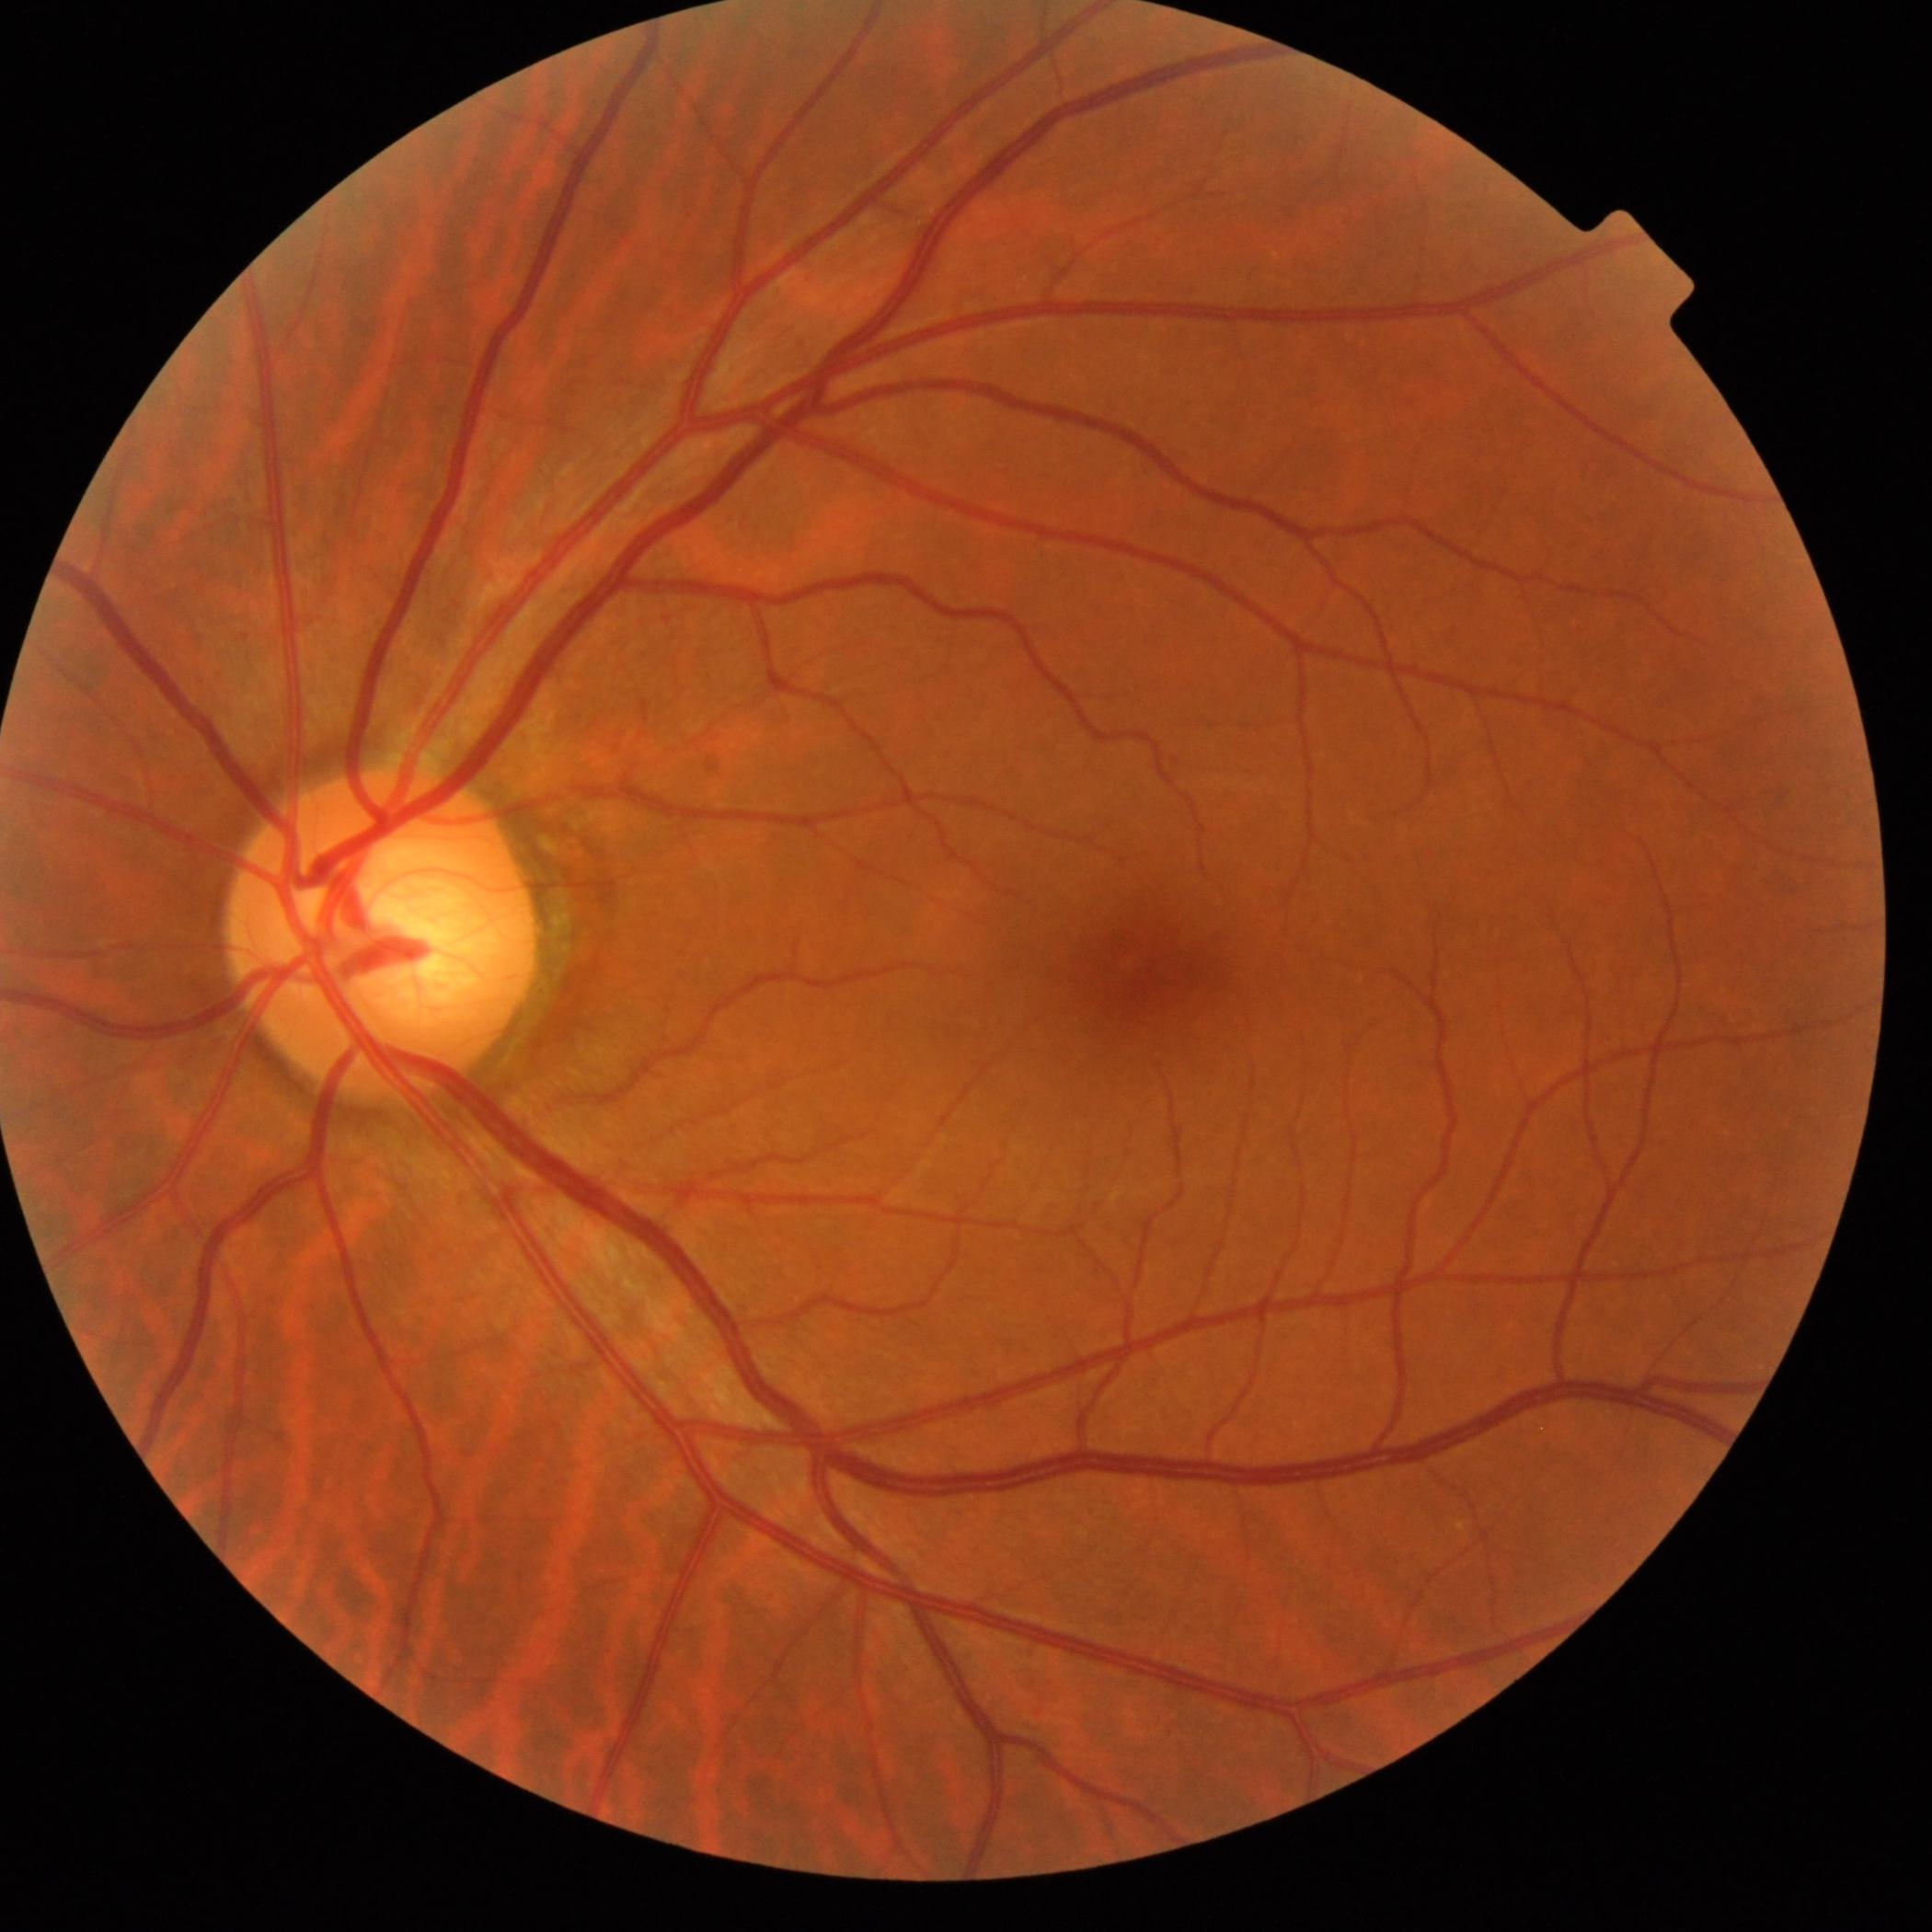
Diabetic retinopathy (DR): grade 0 (no apparent retinopathy).